2352x1568px · 45° FOV — 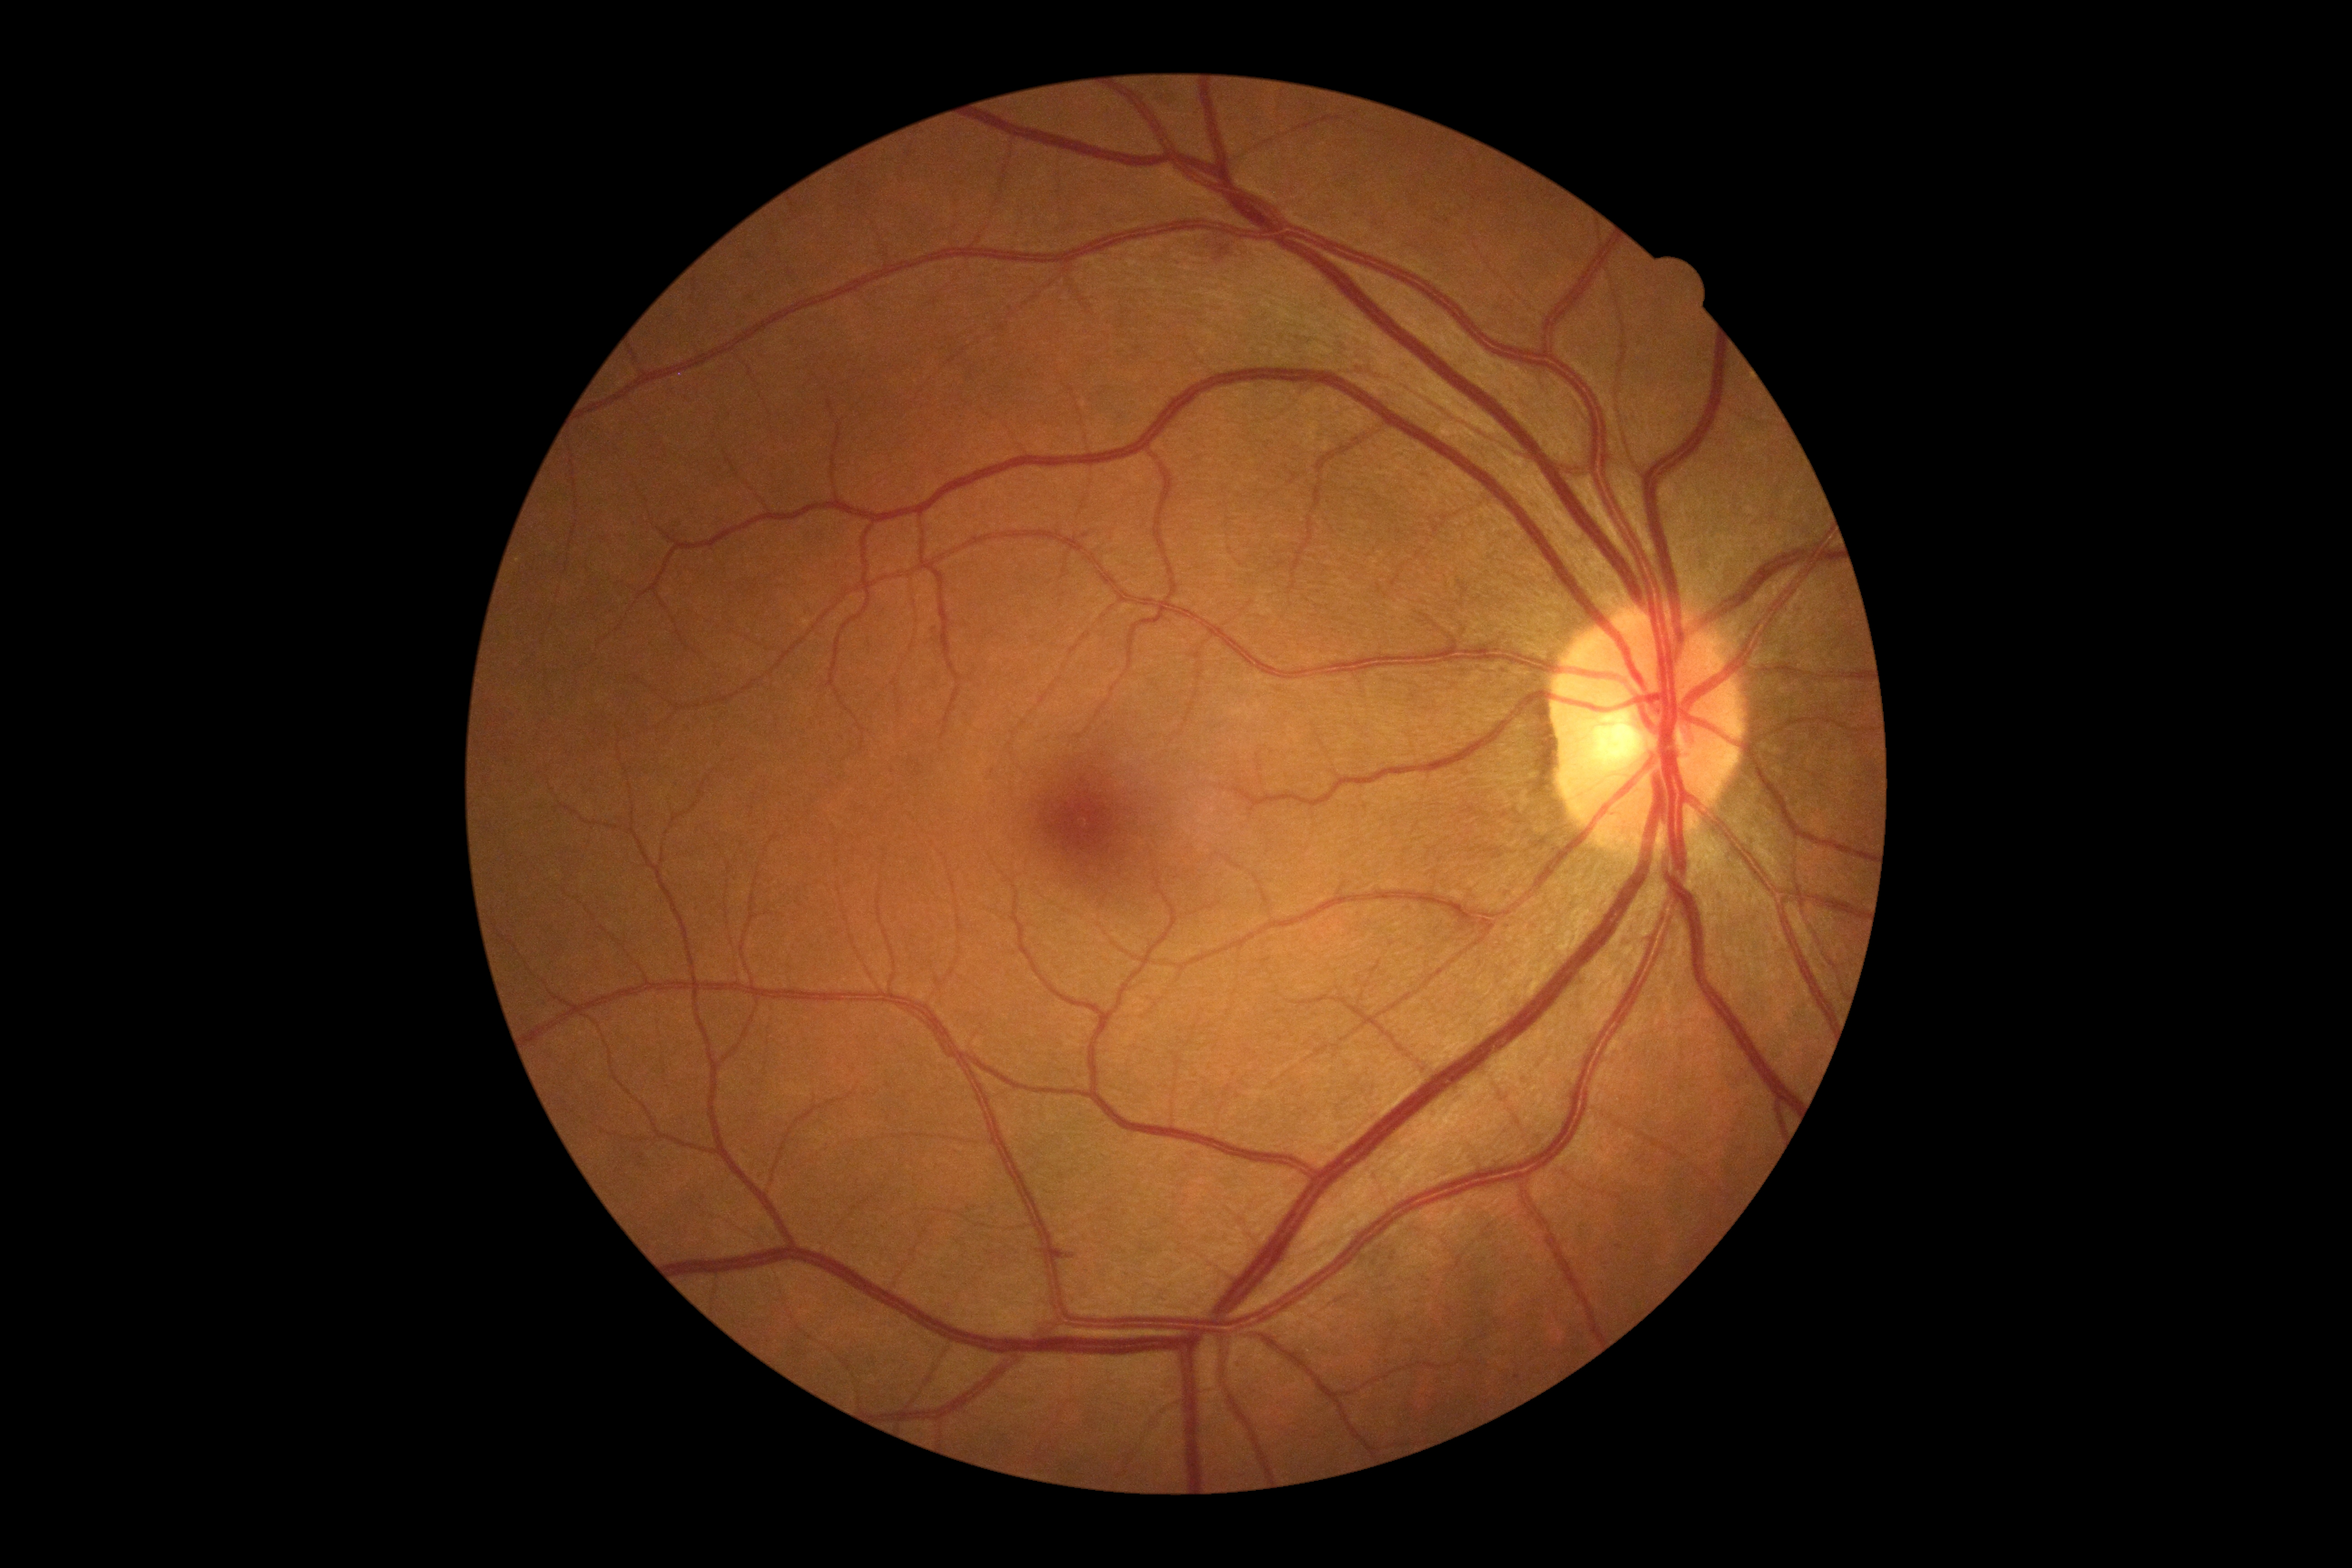

{
  "dr_grade": "2"
}